45 degree fundus photograph; diabetic retinopathy graded by the modified Davis classification; nonmydriatic fundus photograph:
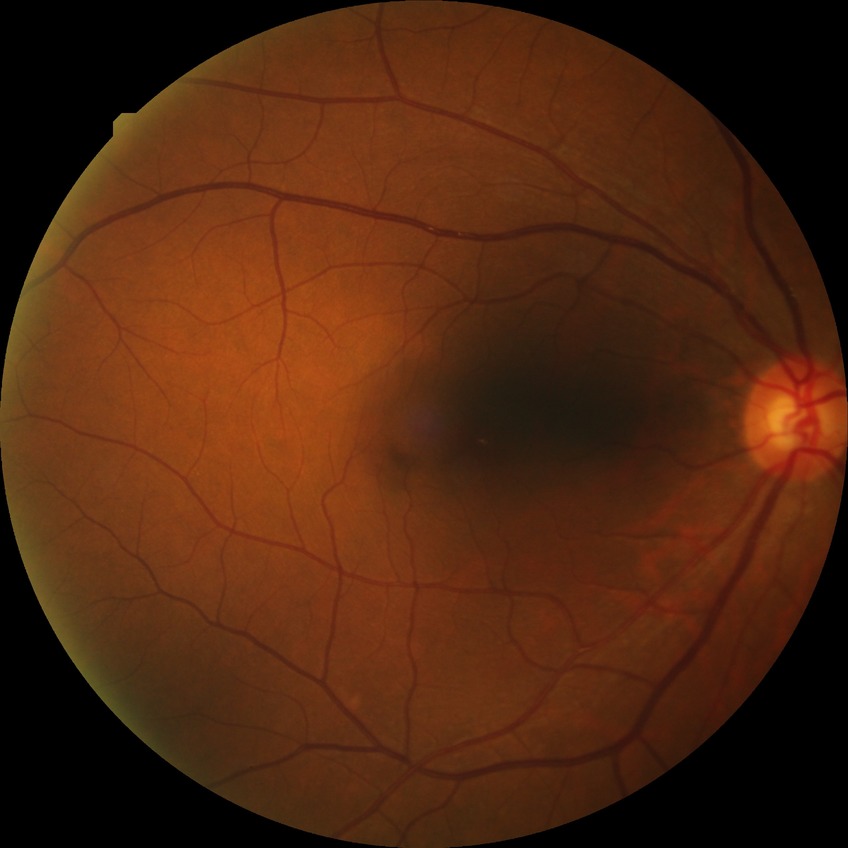
Assessment:
– modified Davis grade — SDR